Captured with the Phoenix ICON (100° field of view). Pediatric retinal photograph (wide-field). 1240 by 1240 pixels — 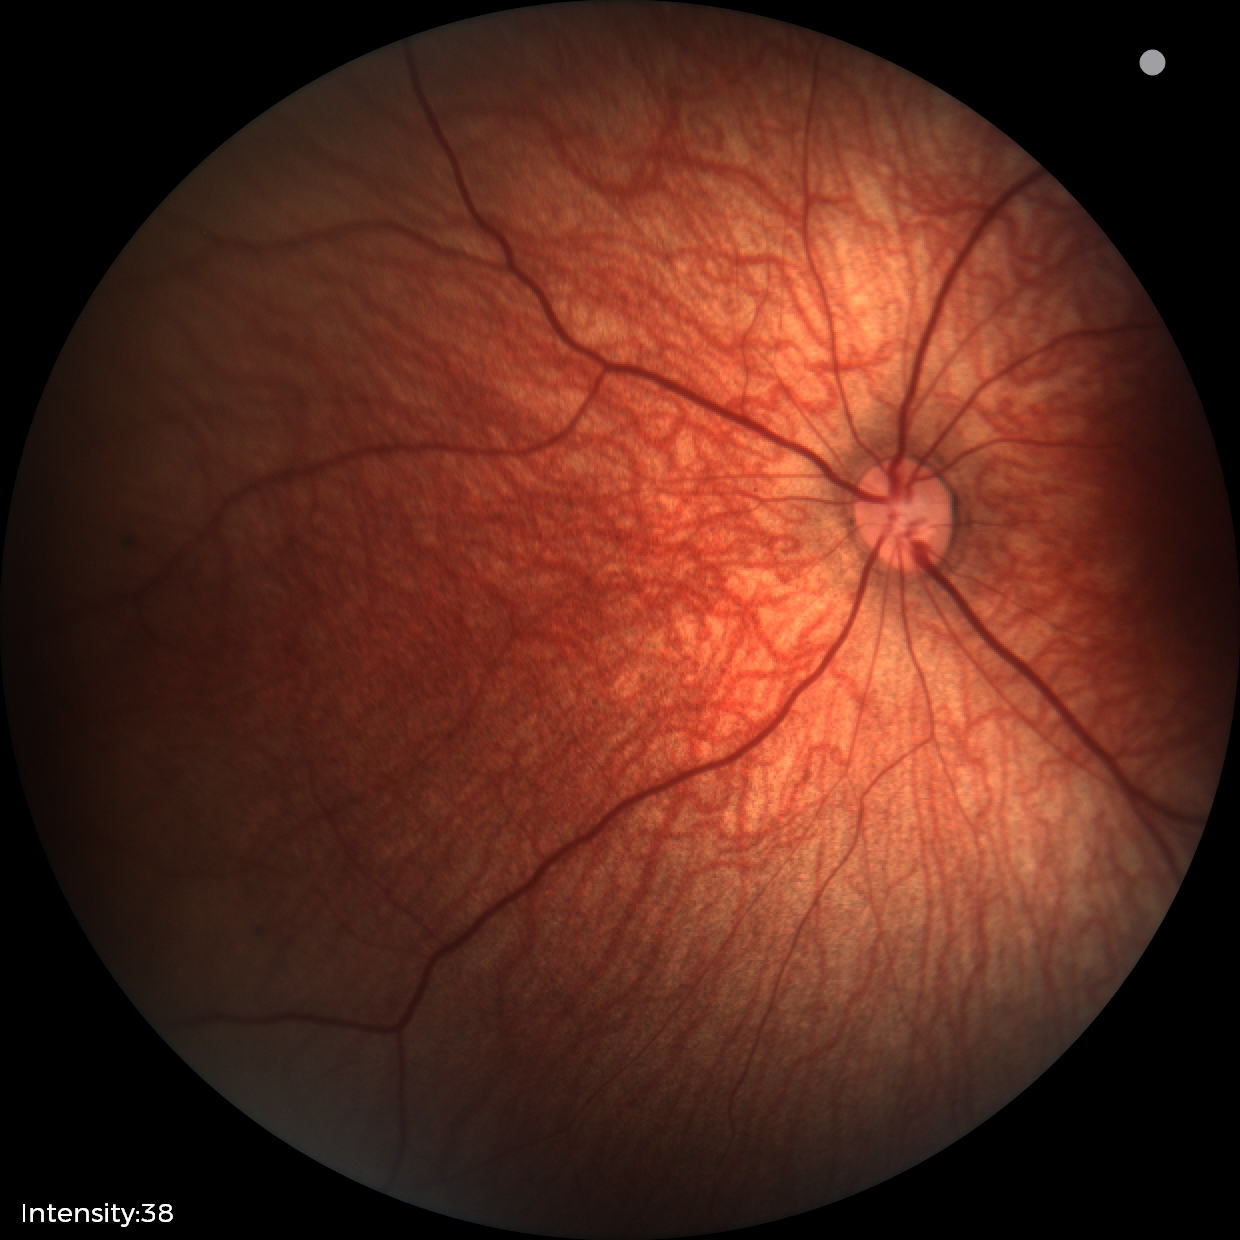
Impression: normal retinal appearance.